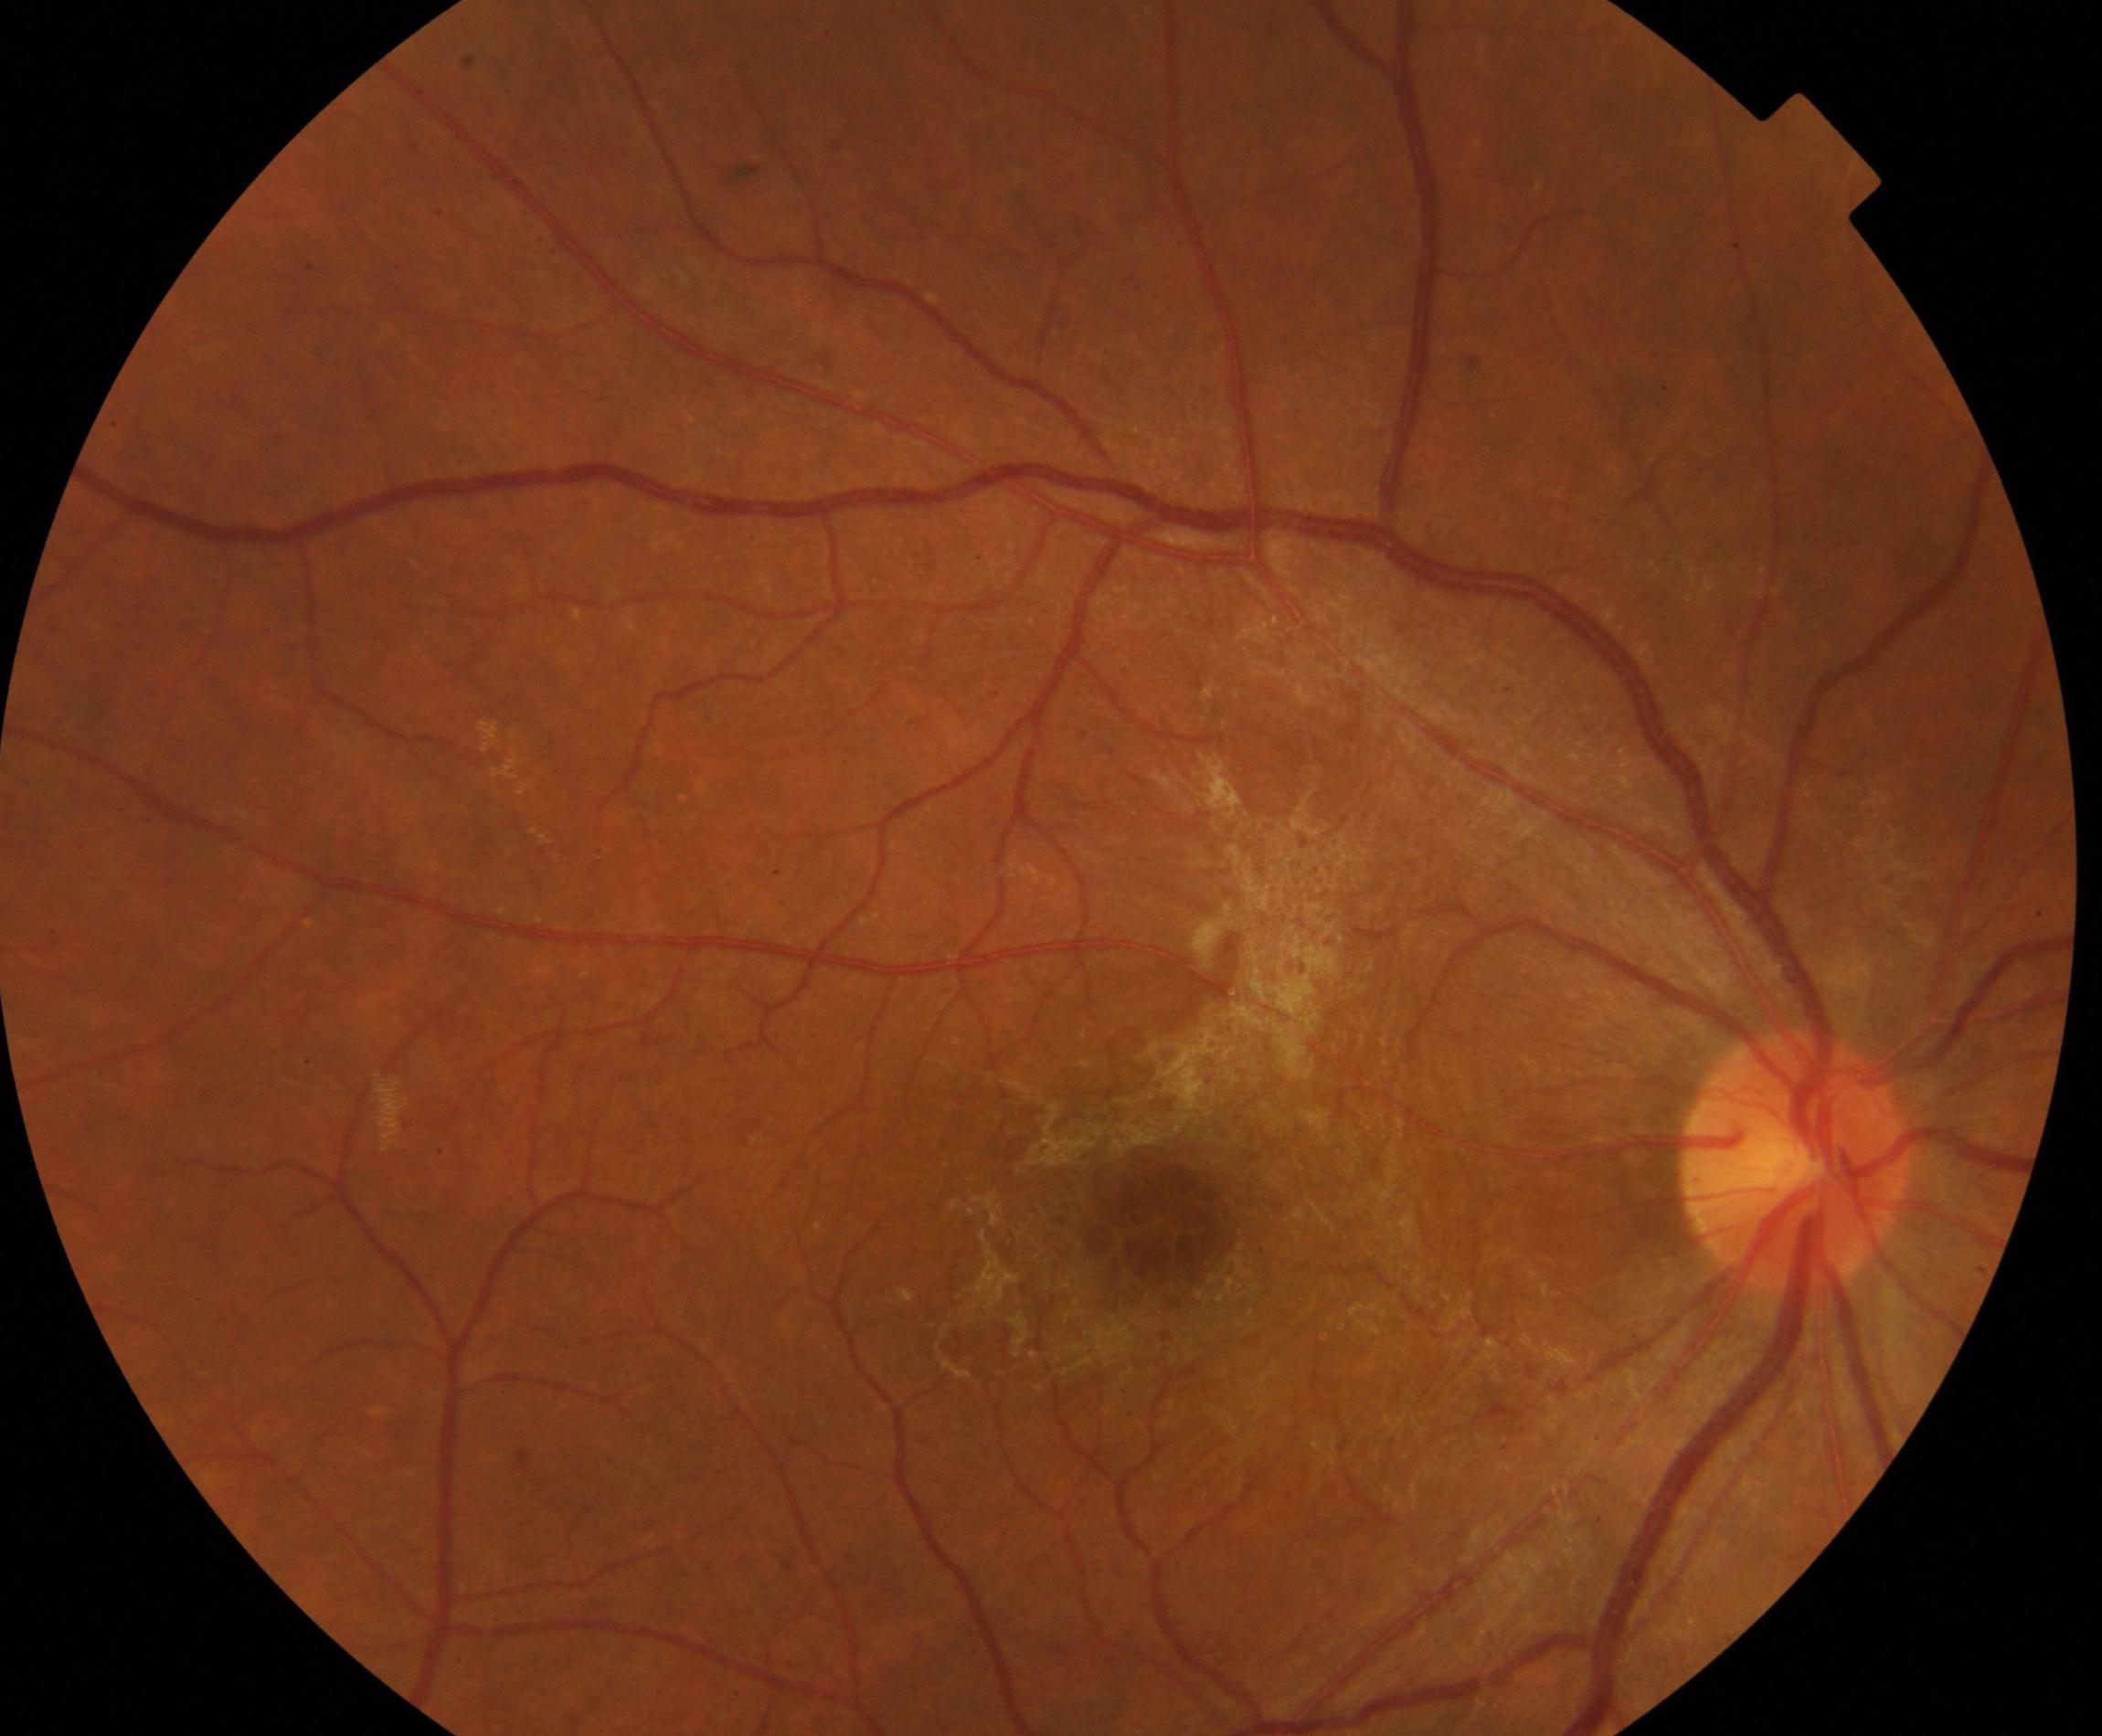

Impression: epiretinal membrane. Defined by a cellophane-sheen sheet on or above the surface of the retina with macular pucker and distortion of blood vessels within the vessel arcades.